NIDEK AFC-230 fundus camera: 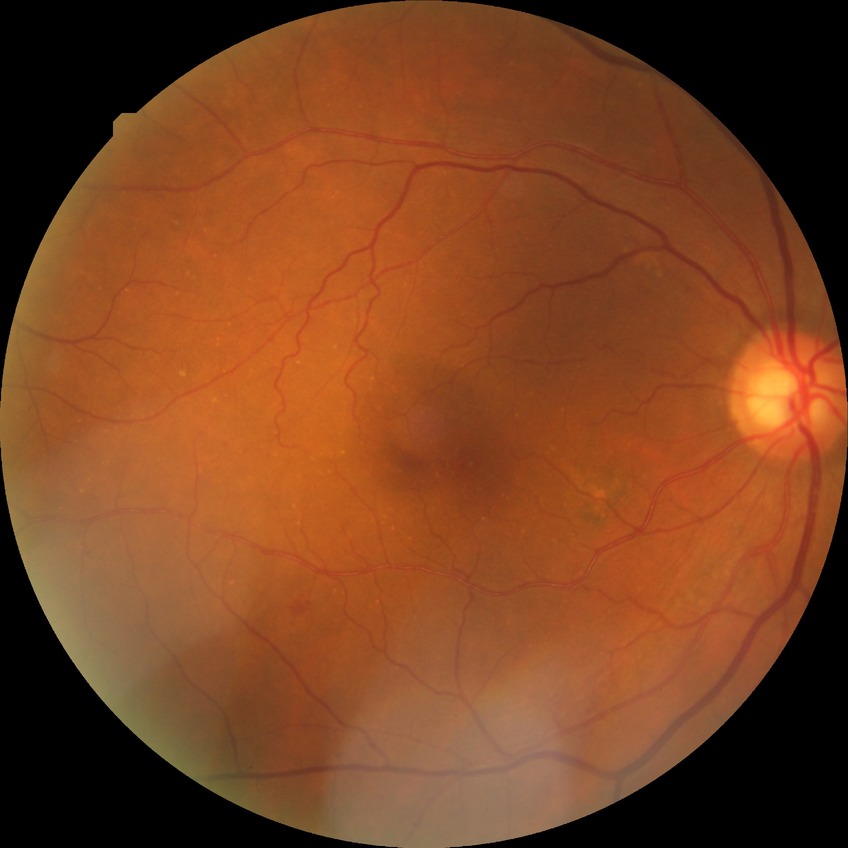 DR severity = NDR.